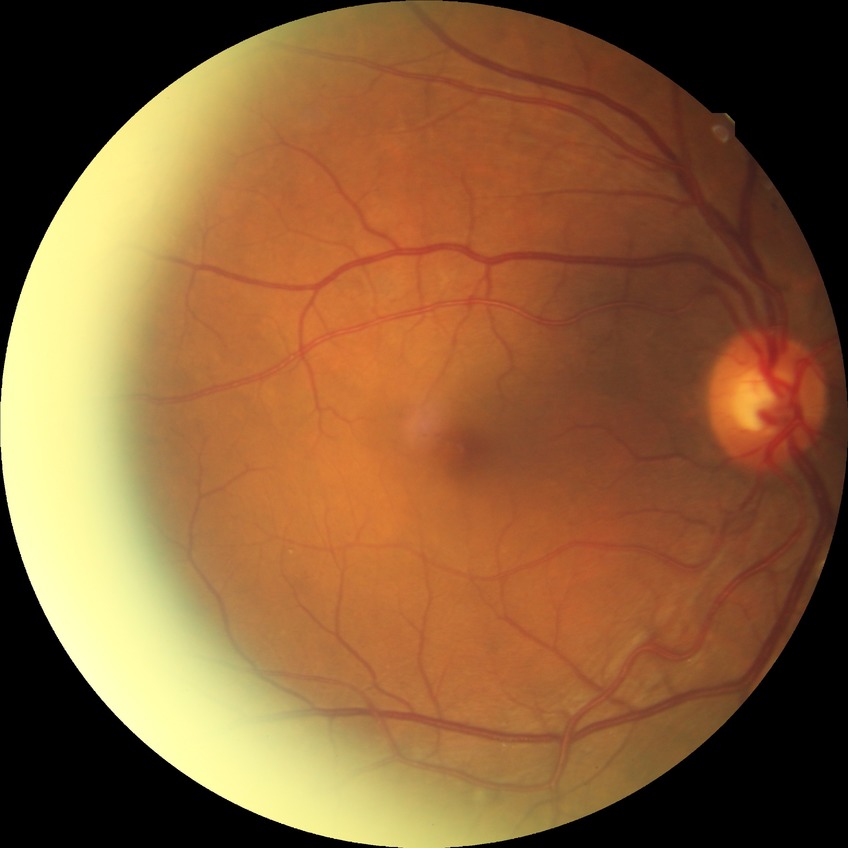
Diabetic retinopathy (DR) is simple diabetic retinopathy (SDR).